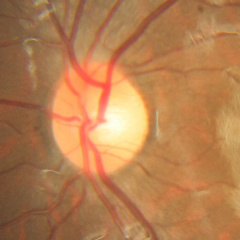
There is evidence of no evidence of glaucoma.